412x310, color fundus photograph — 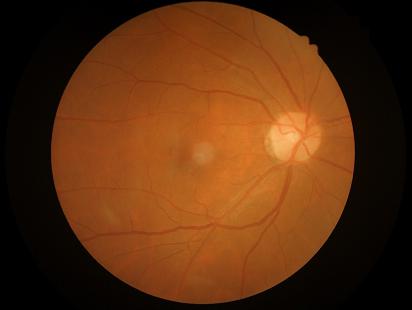 Overall quality is good and the image is gradable. No noticeable blur. Adequate contrast for distinguishing structures. Illumination and color balance are good.